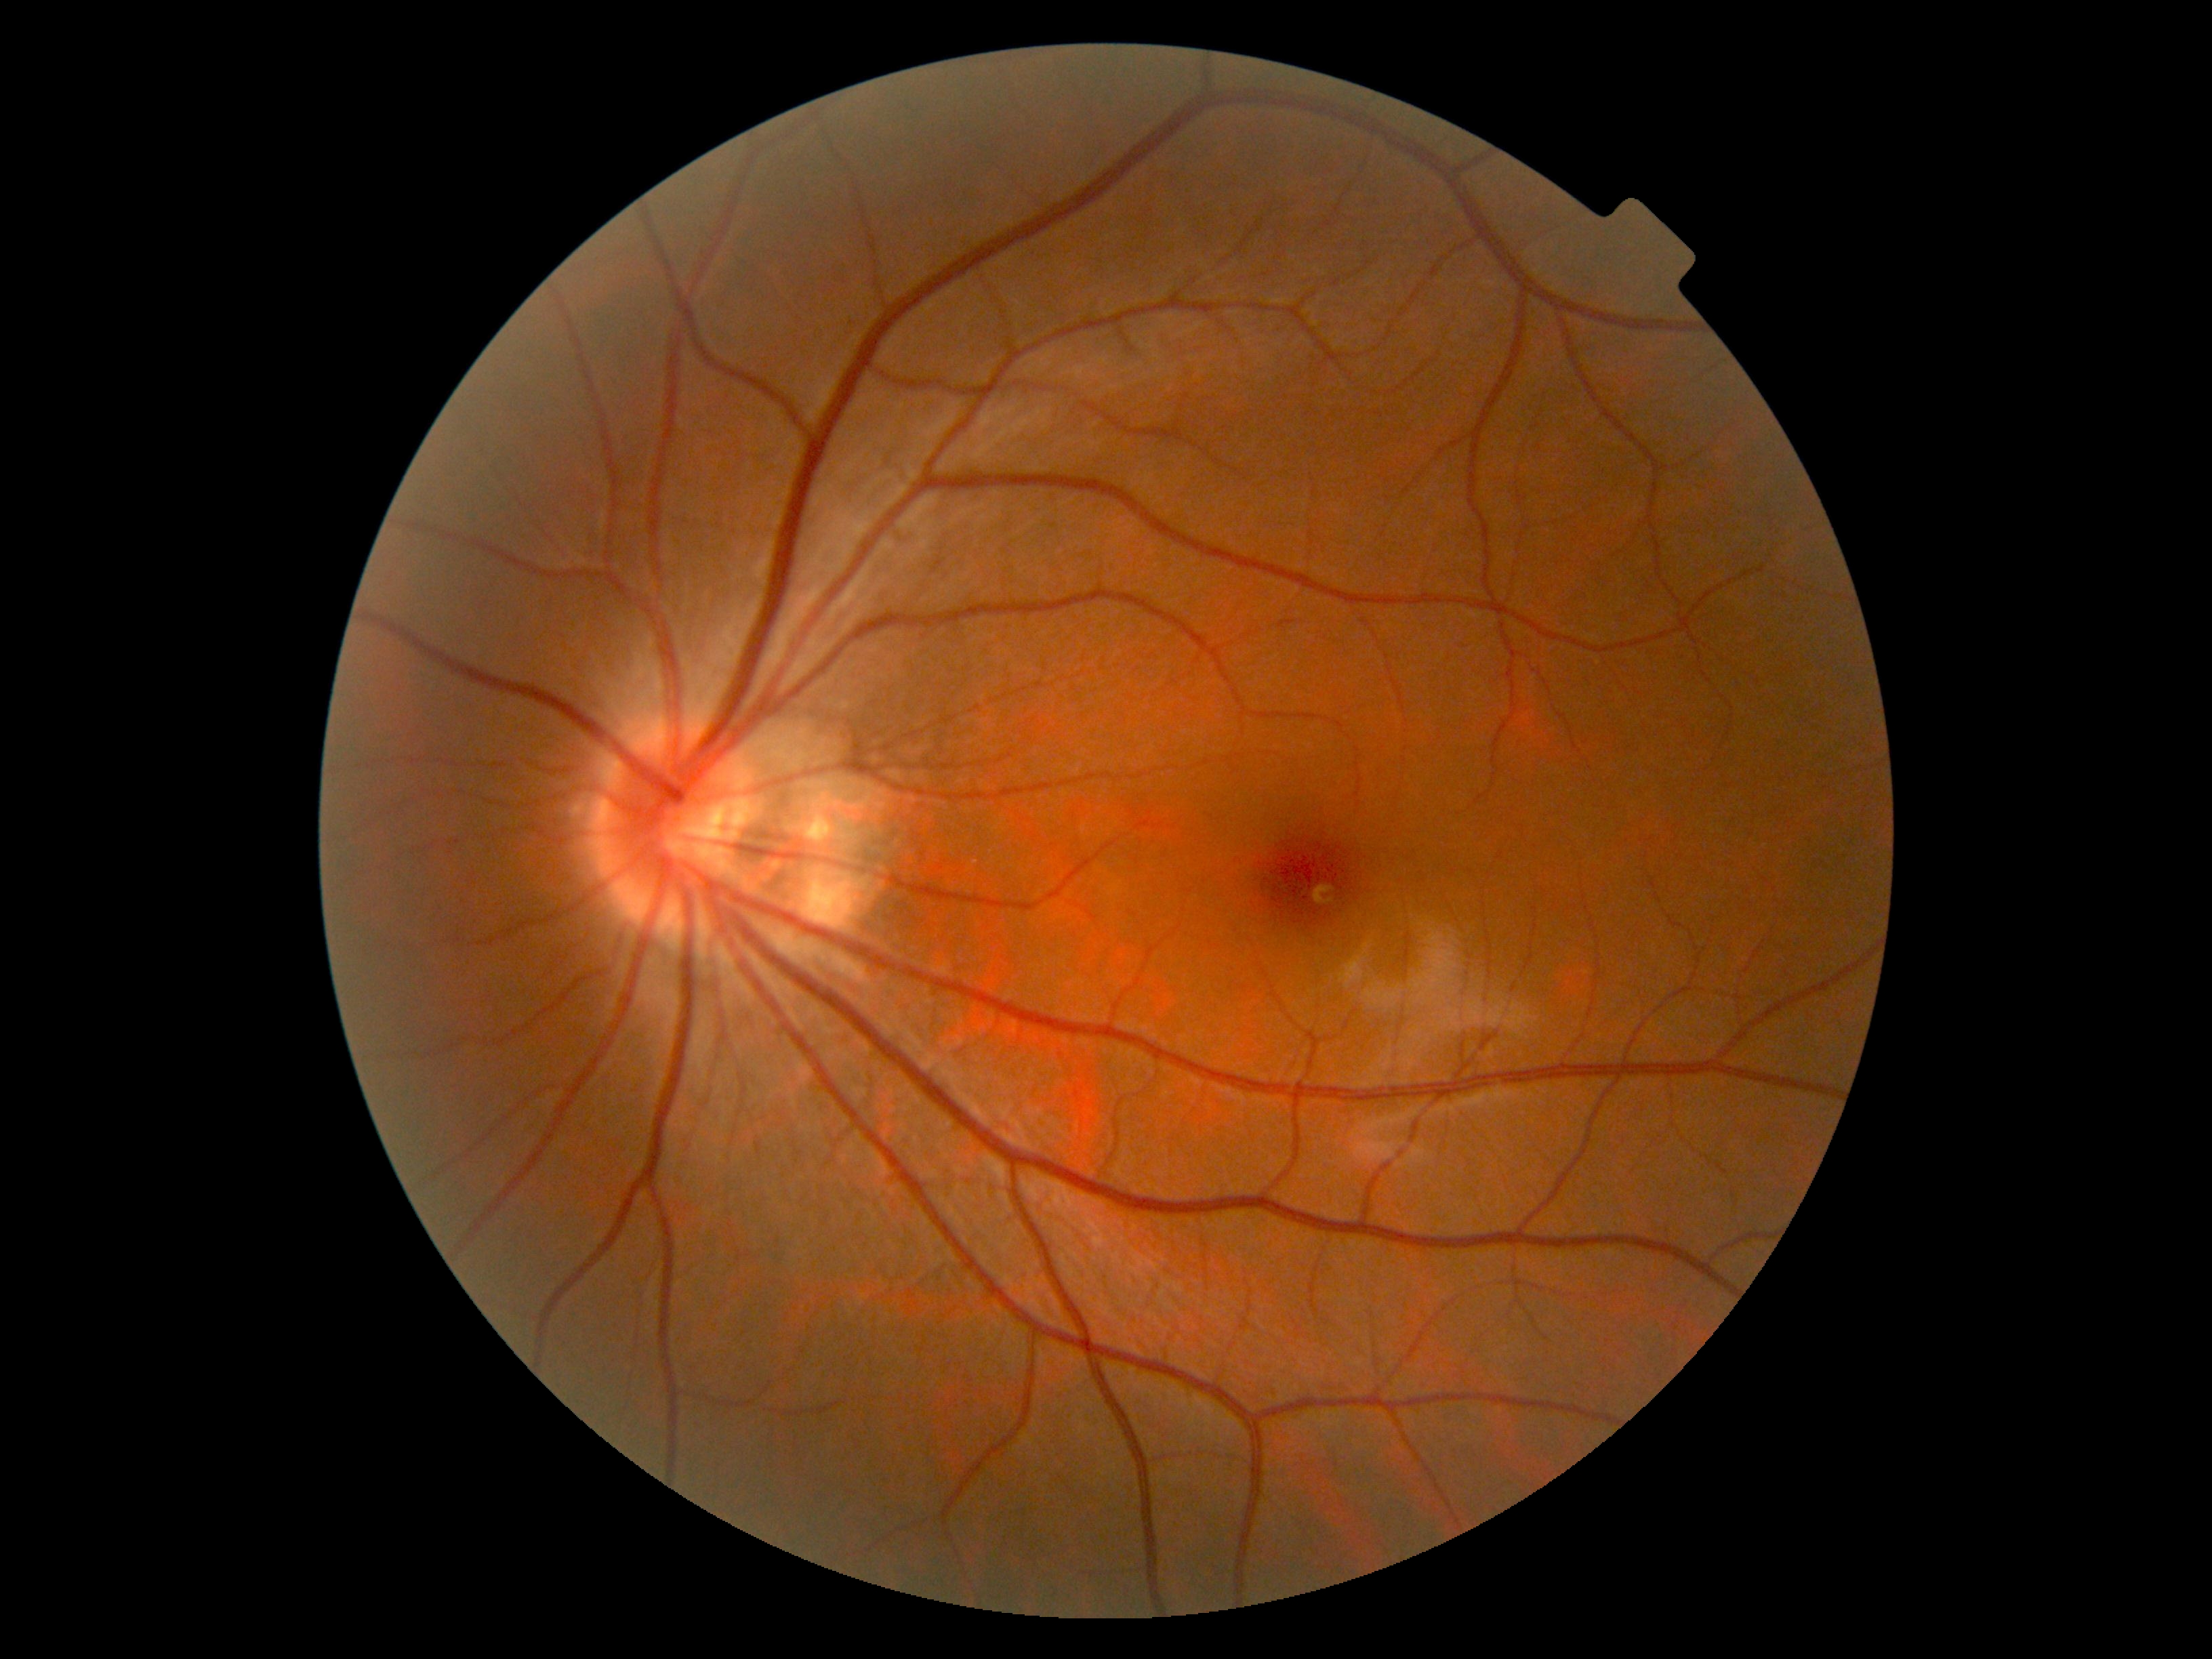
No apparent diabetic retinopathy. DR grade: no apparent retinopathy (0).